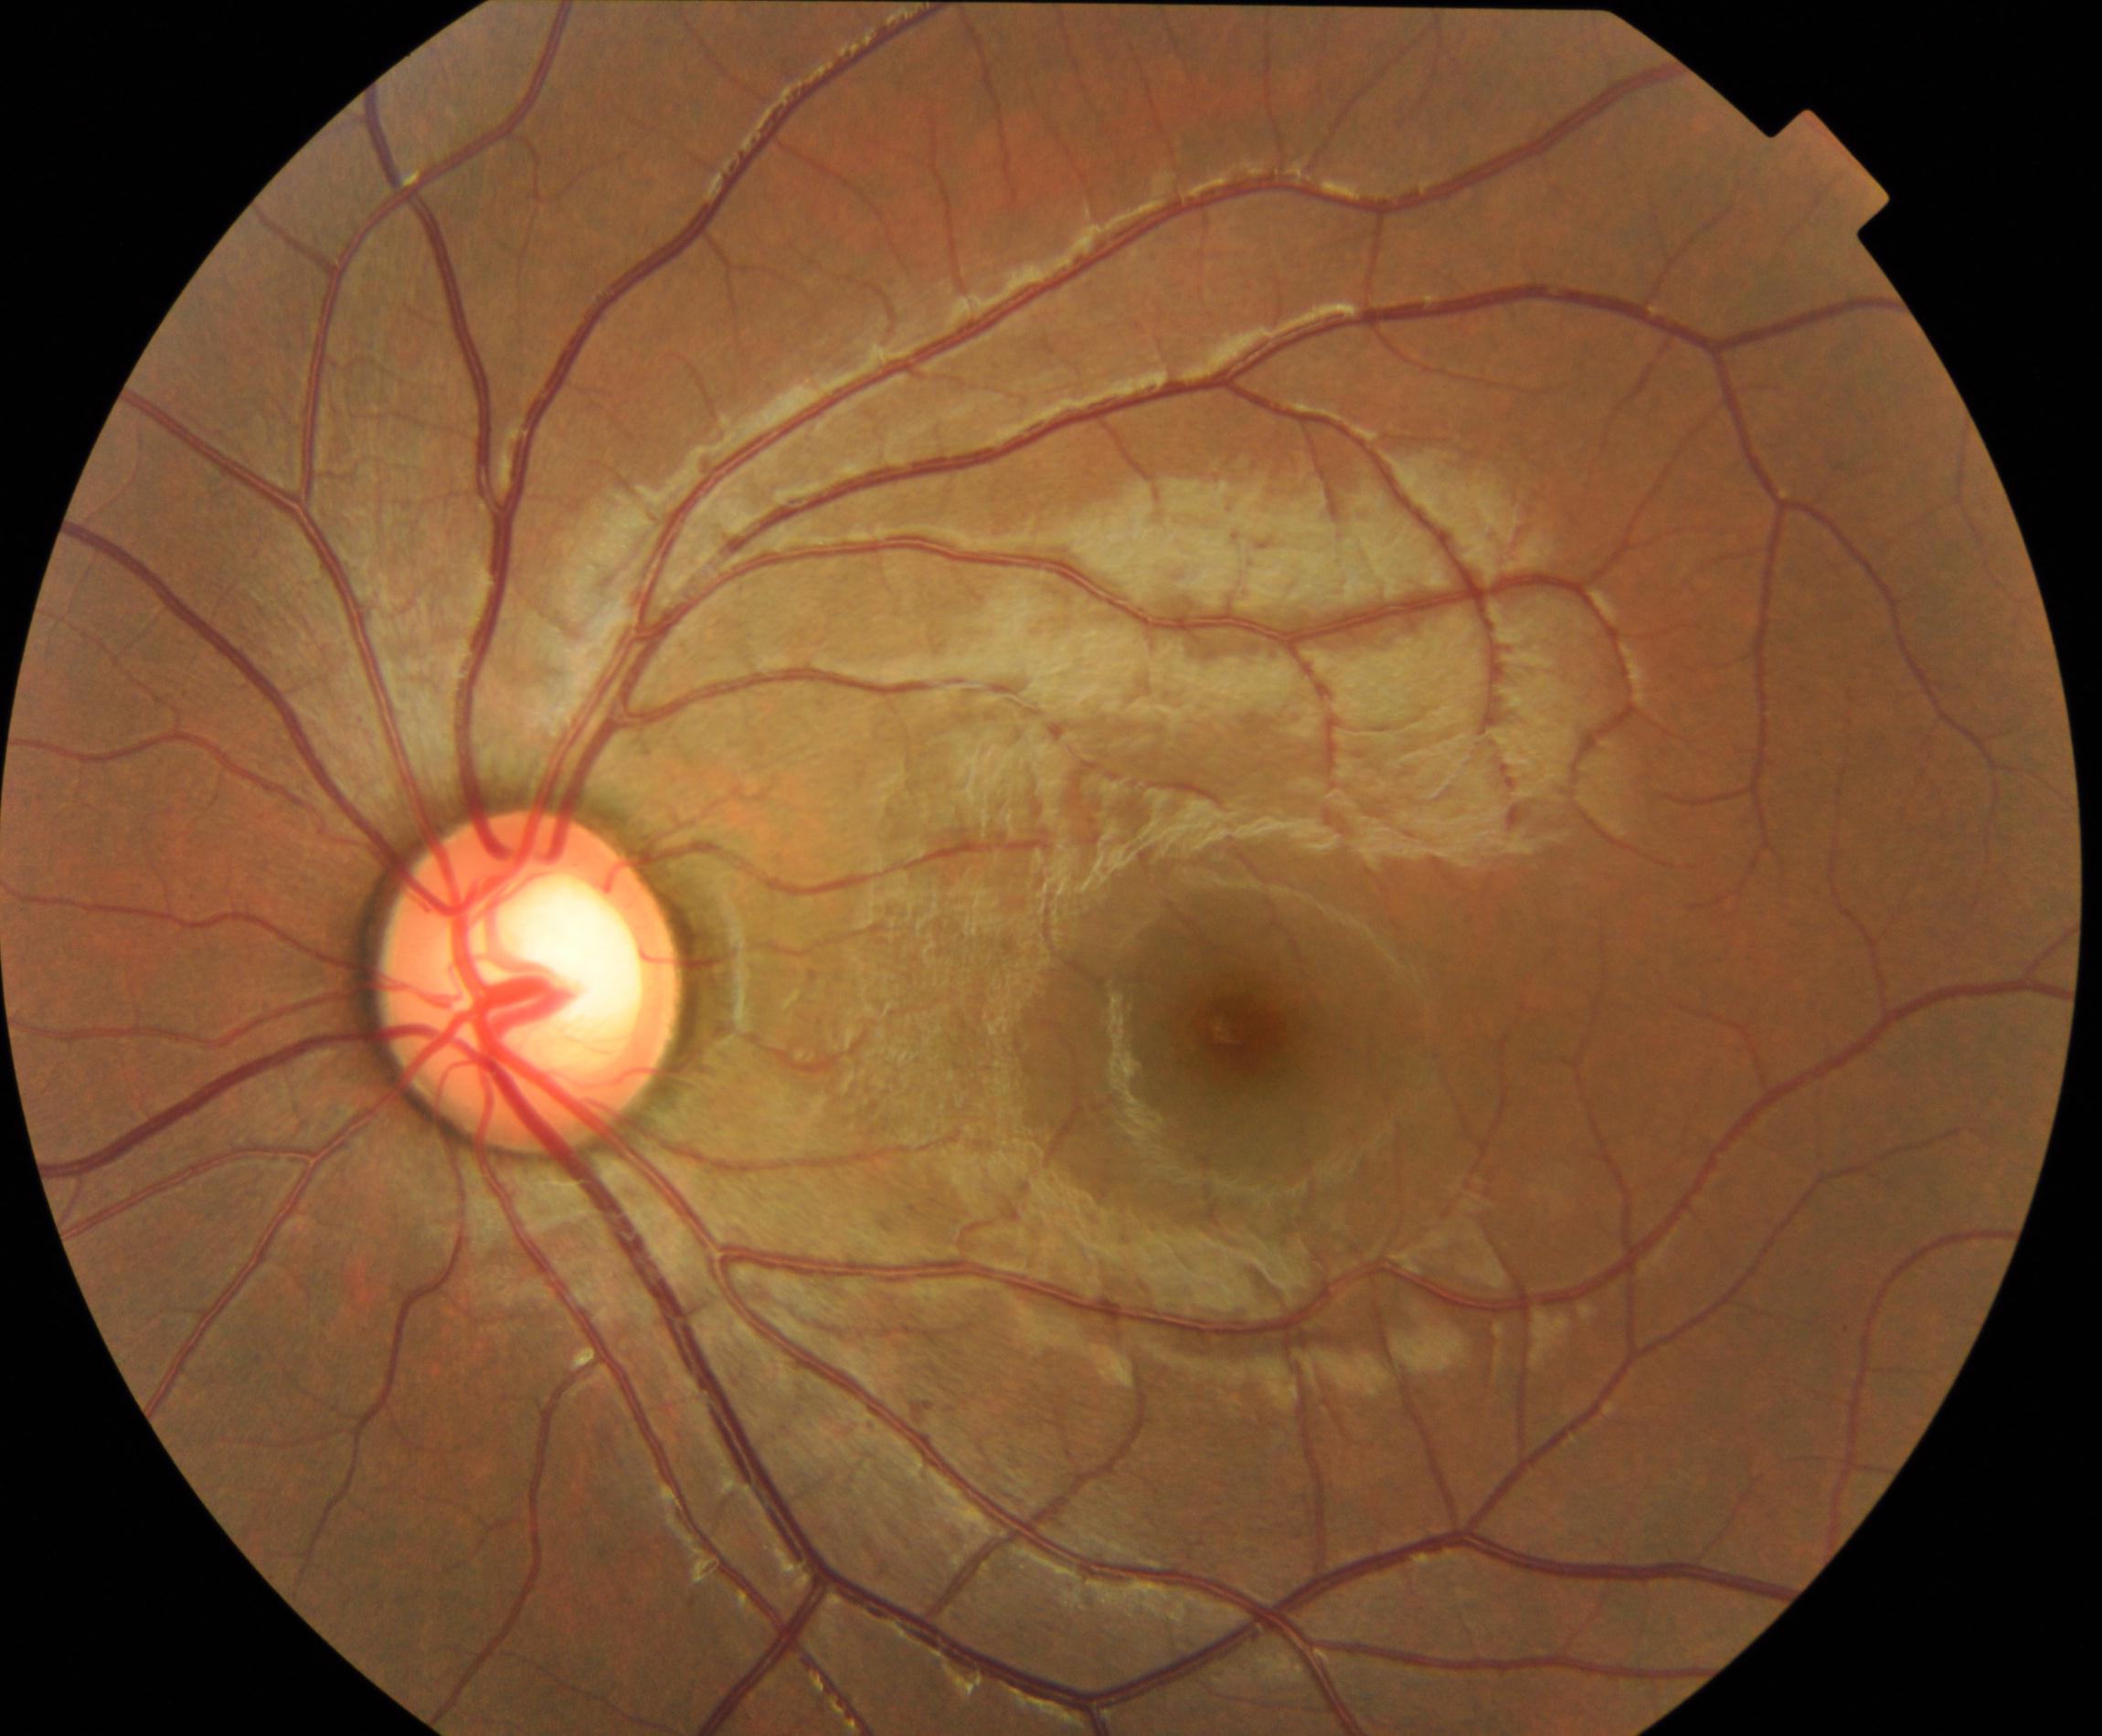

Primary finding: large optic cup.